512x512, retinal fundus photograph:
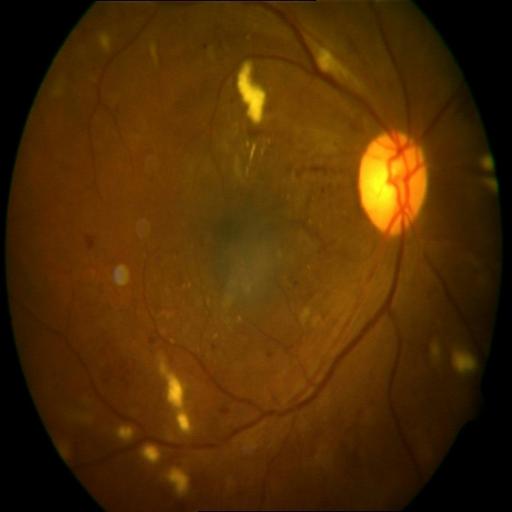 Findings consistent with cotton wool spots (CWS), cystoid macular edema (CME) & hemorrhagic retinopathy (HR).